CFP — 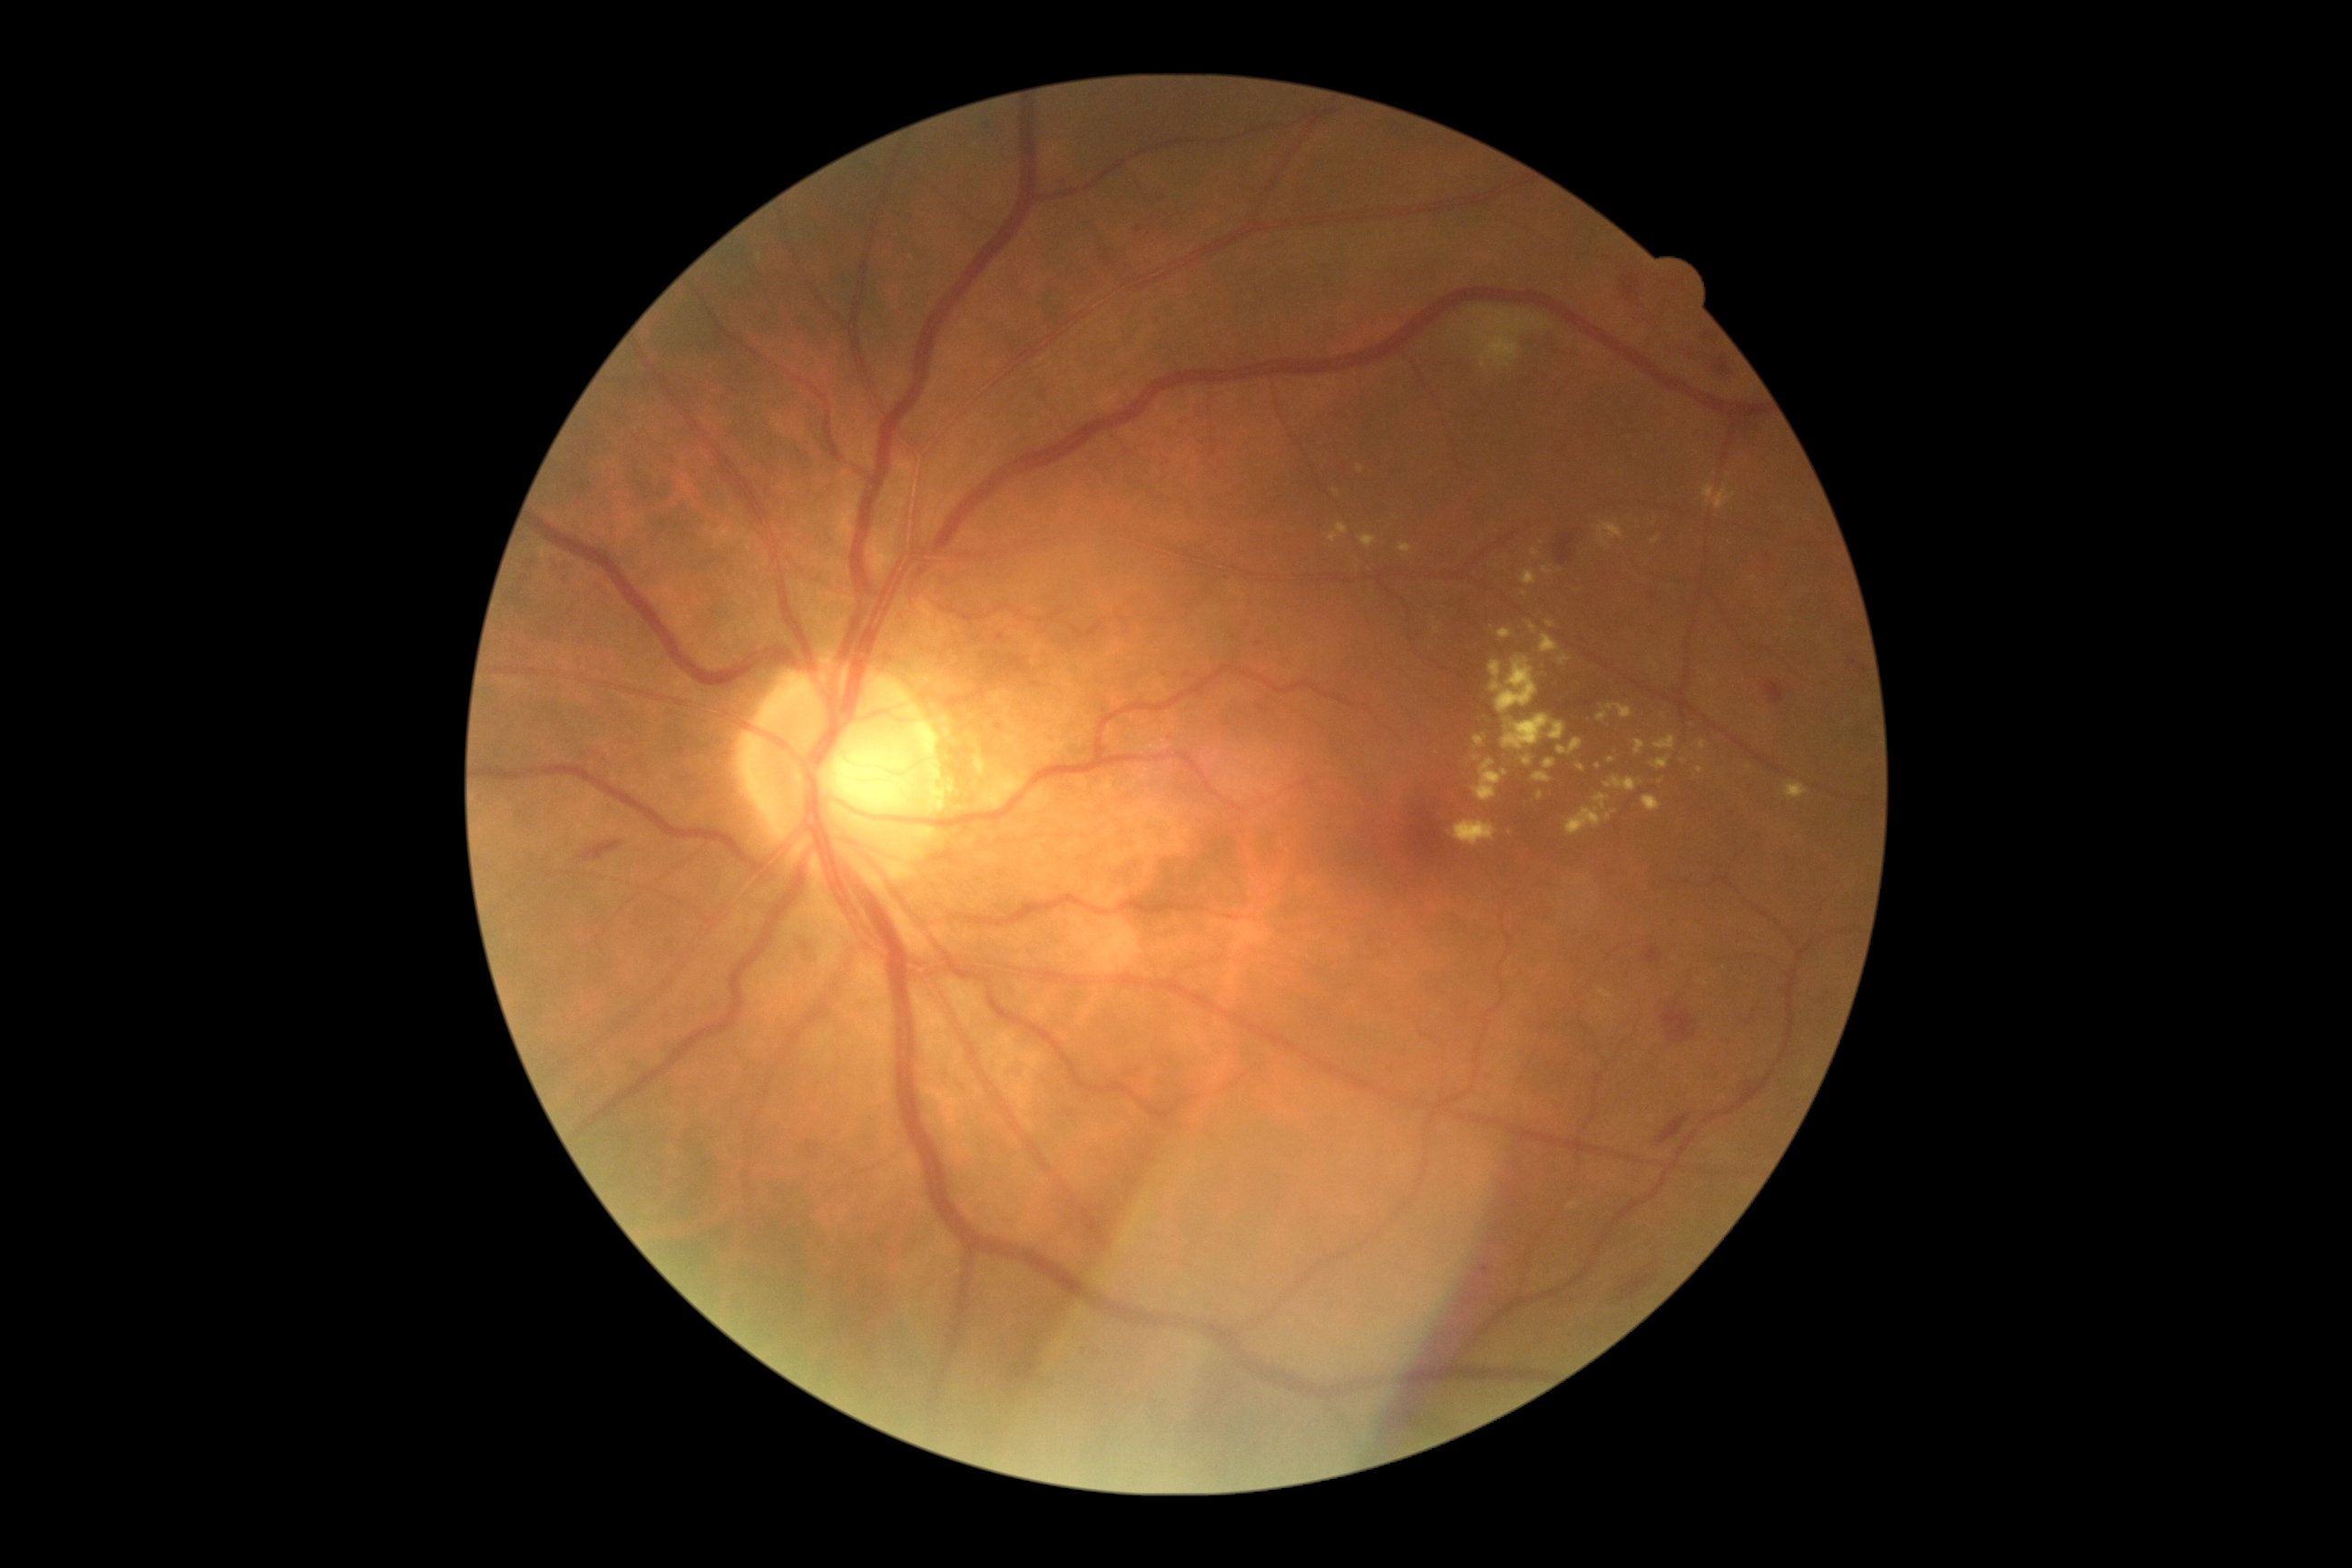

Diabetic retinopathy severity: grade 2 (moderate NPDR) — more than just microaneurysms but less than severe NPDR.